45 degree fundus photograph · nonmydriatic fundus photograph · color fundus photograph — 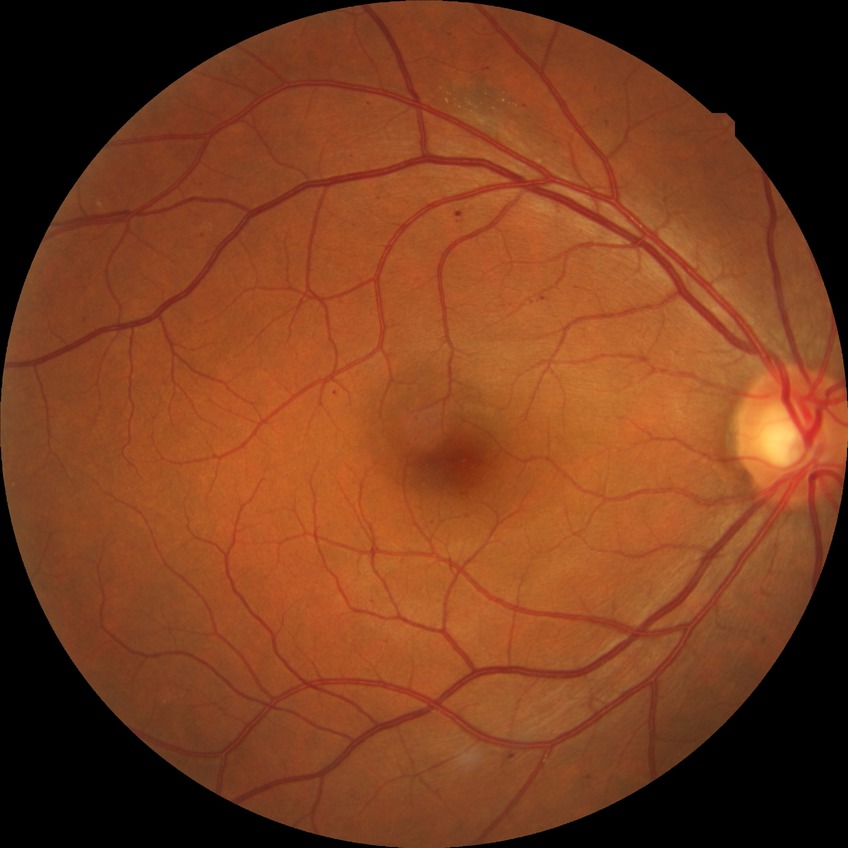

DR class: non-proliferative diabetic retinopathy; diabetic retinopathy (DR): simple diabetic retinopathy (SDR).